Retinal fundus photograph. 45° field of view. 2184x1690
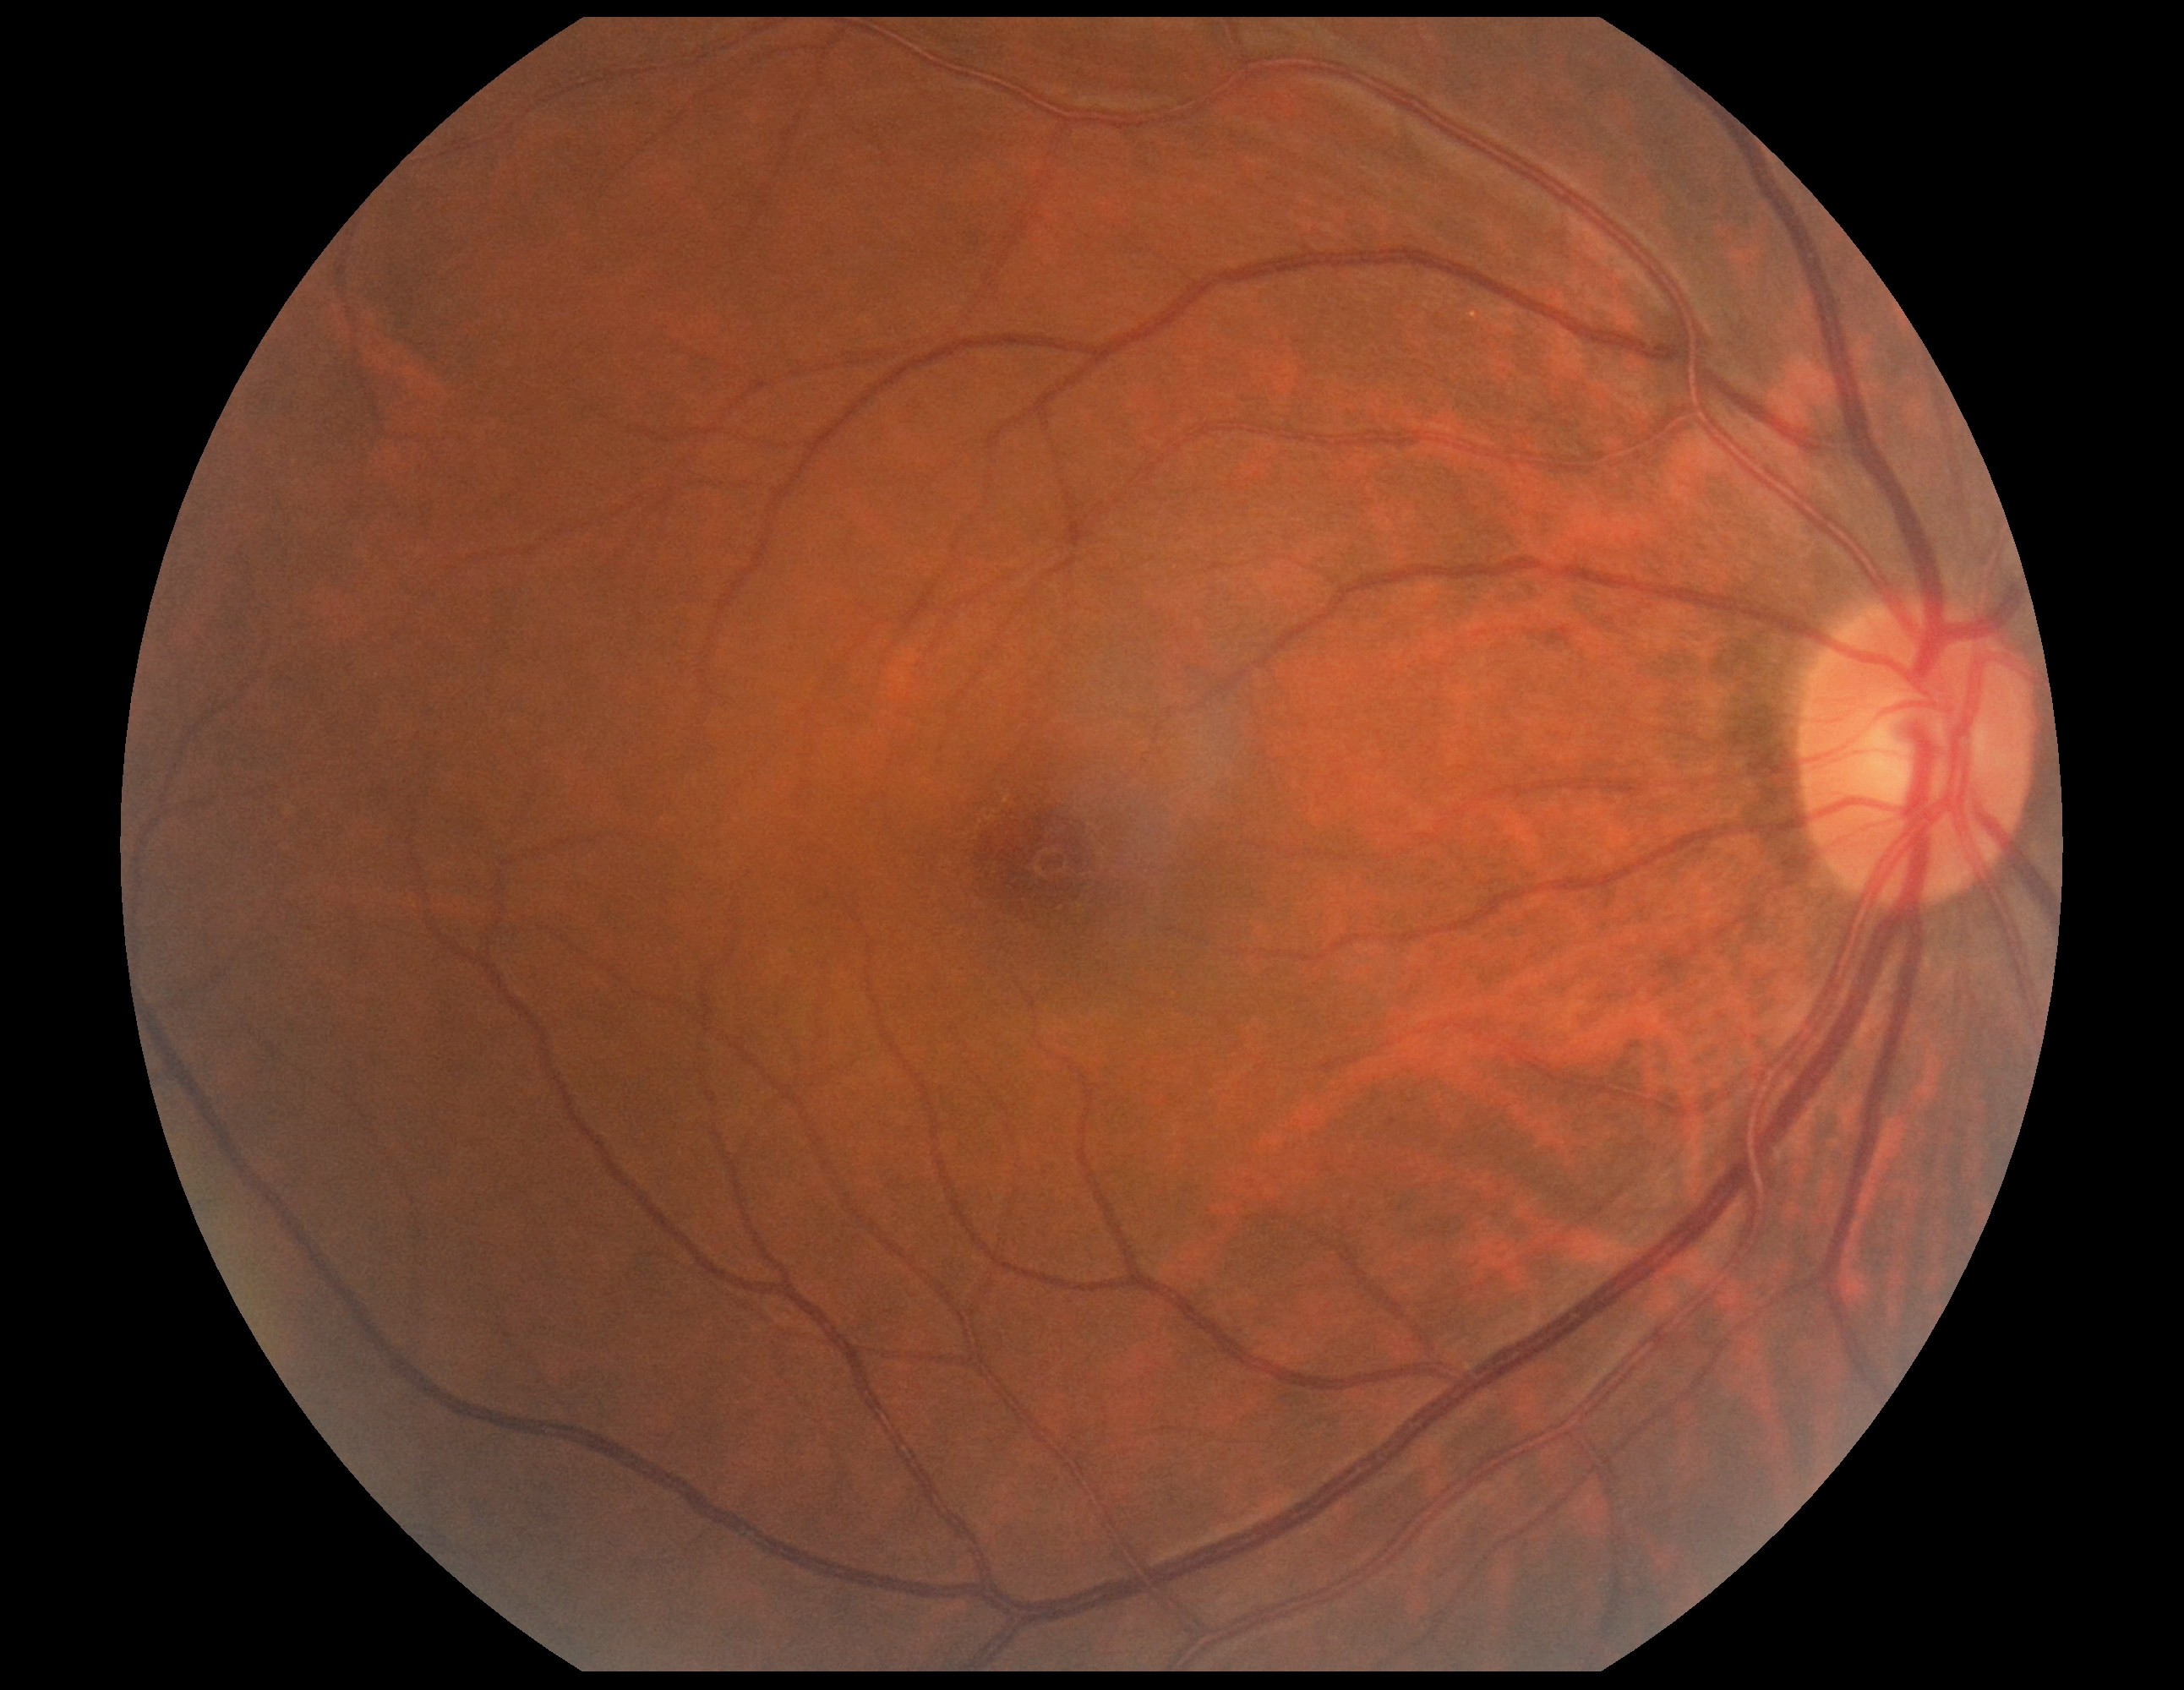

* diabetic retinopathy (DR) — no apparent retinopathy (grade 0) — no visible signs of diabetic retinopathy